Wide-field fundus photograph from neonatal ROP screening — 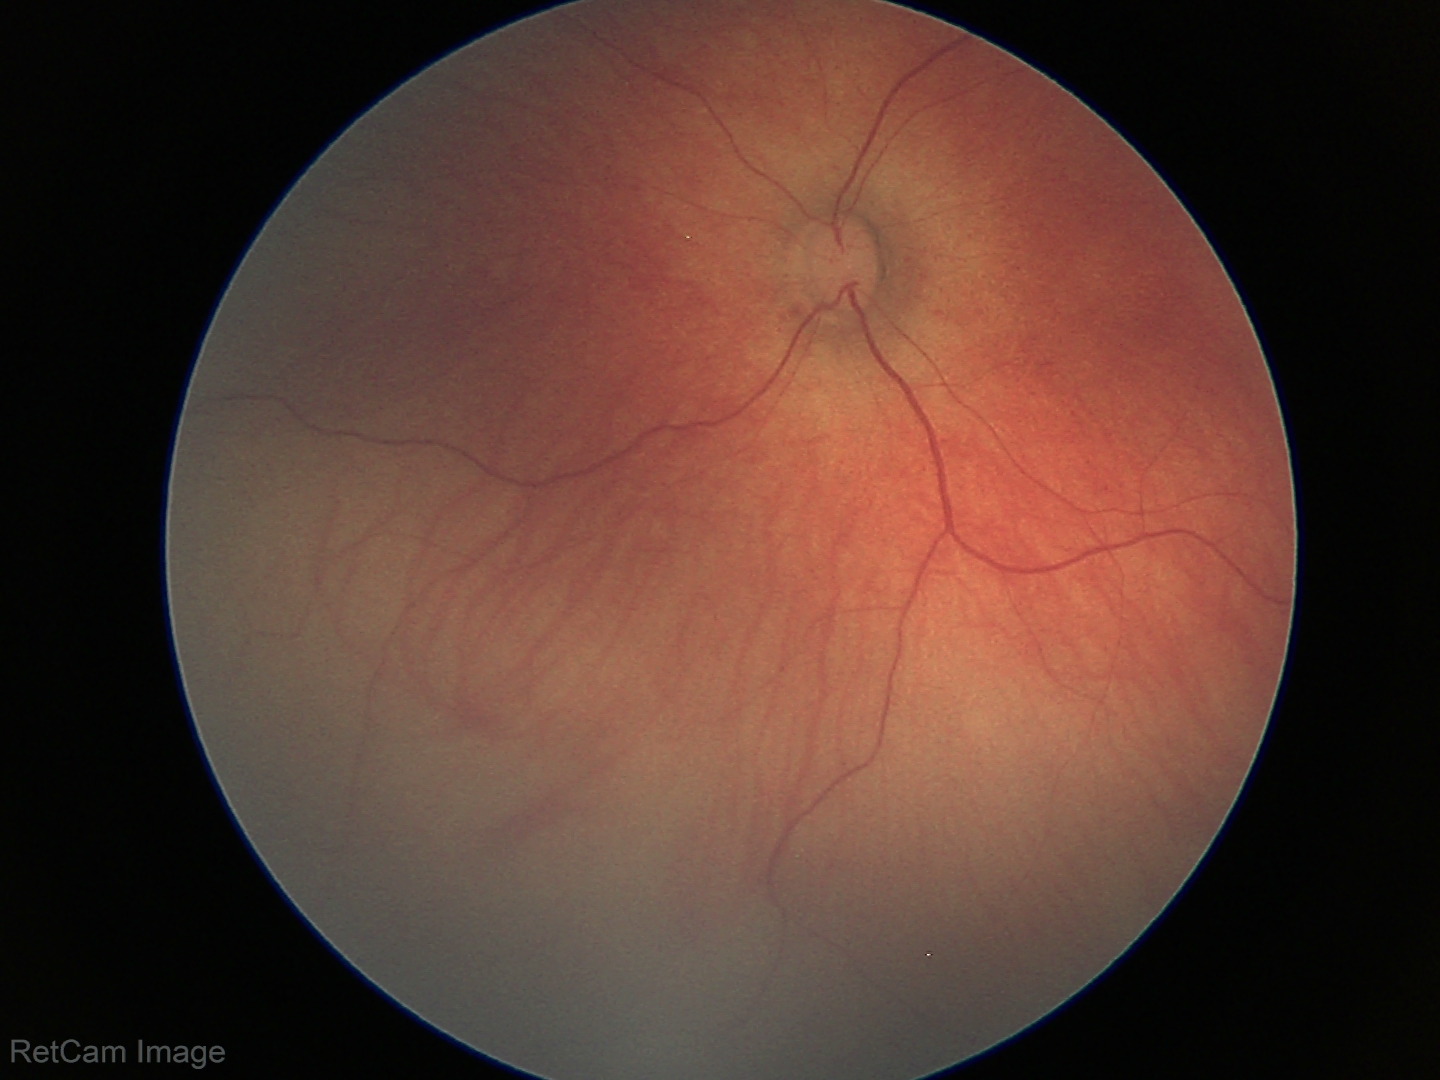 Physiological retinal appearance for postconceptual age.